1920 by 1440 pixels.
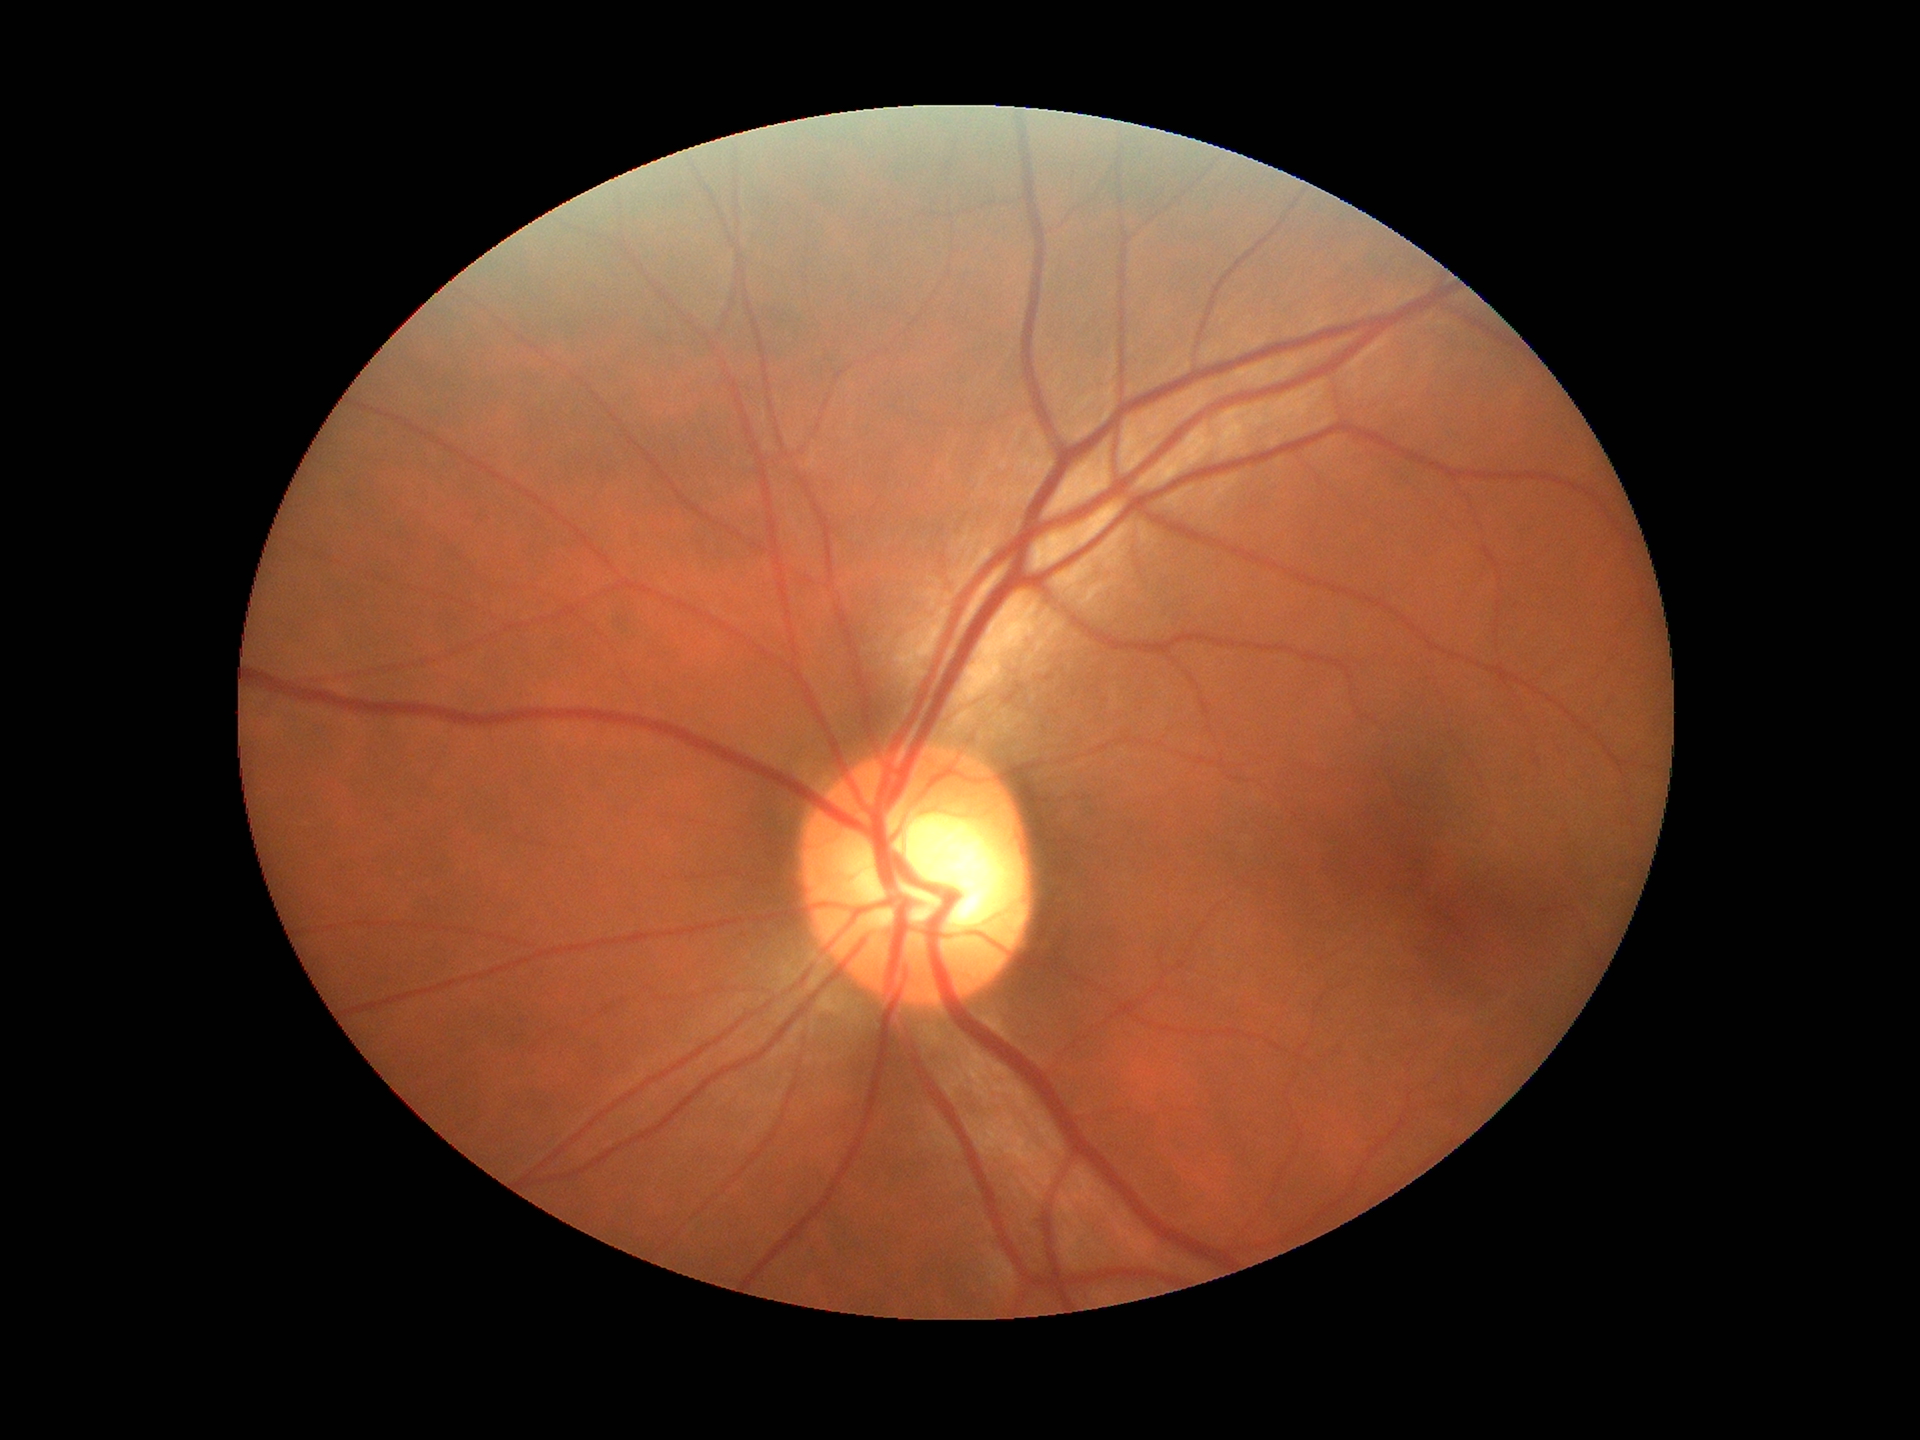 Glaucoma screening: no suspicious findings
vertical cup-disc ratio (VCDR): 0.55